Acquired on the Clarity RetCam 3 · pediatric retinal photograph (wide-field):
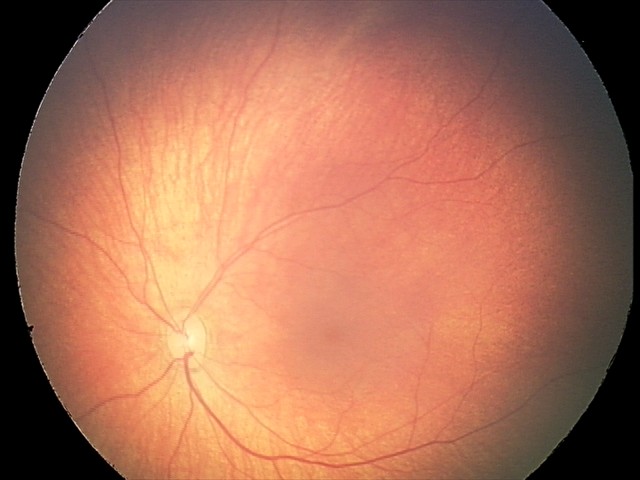 From an examination with diagnosis of retinal hemorrhages.